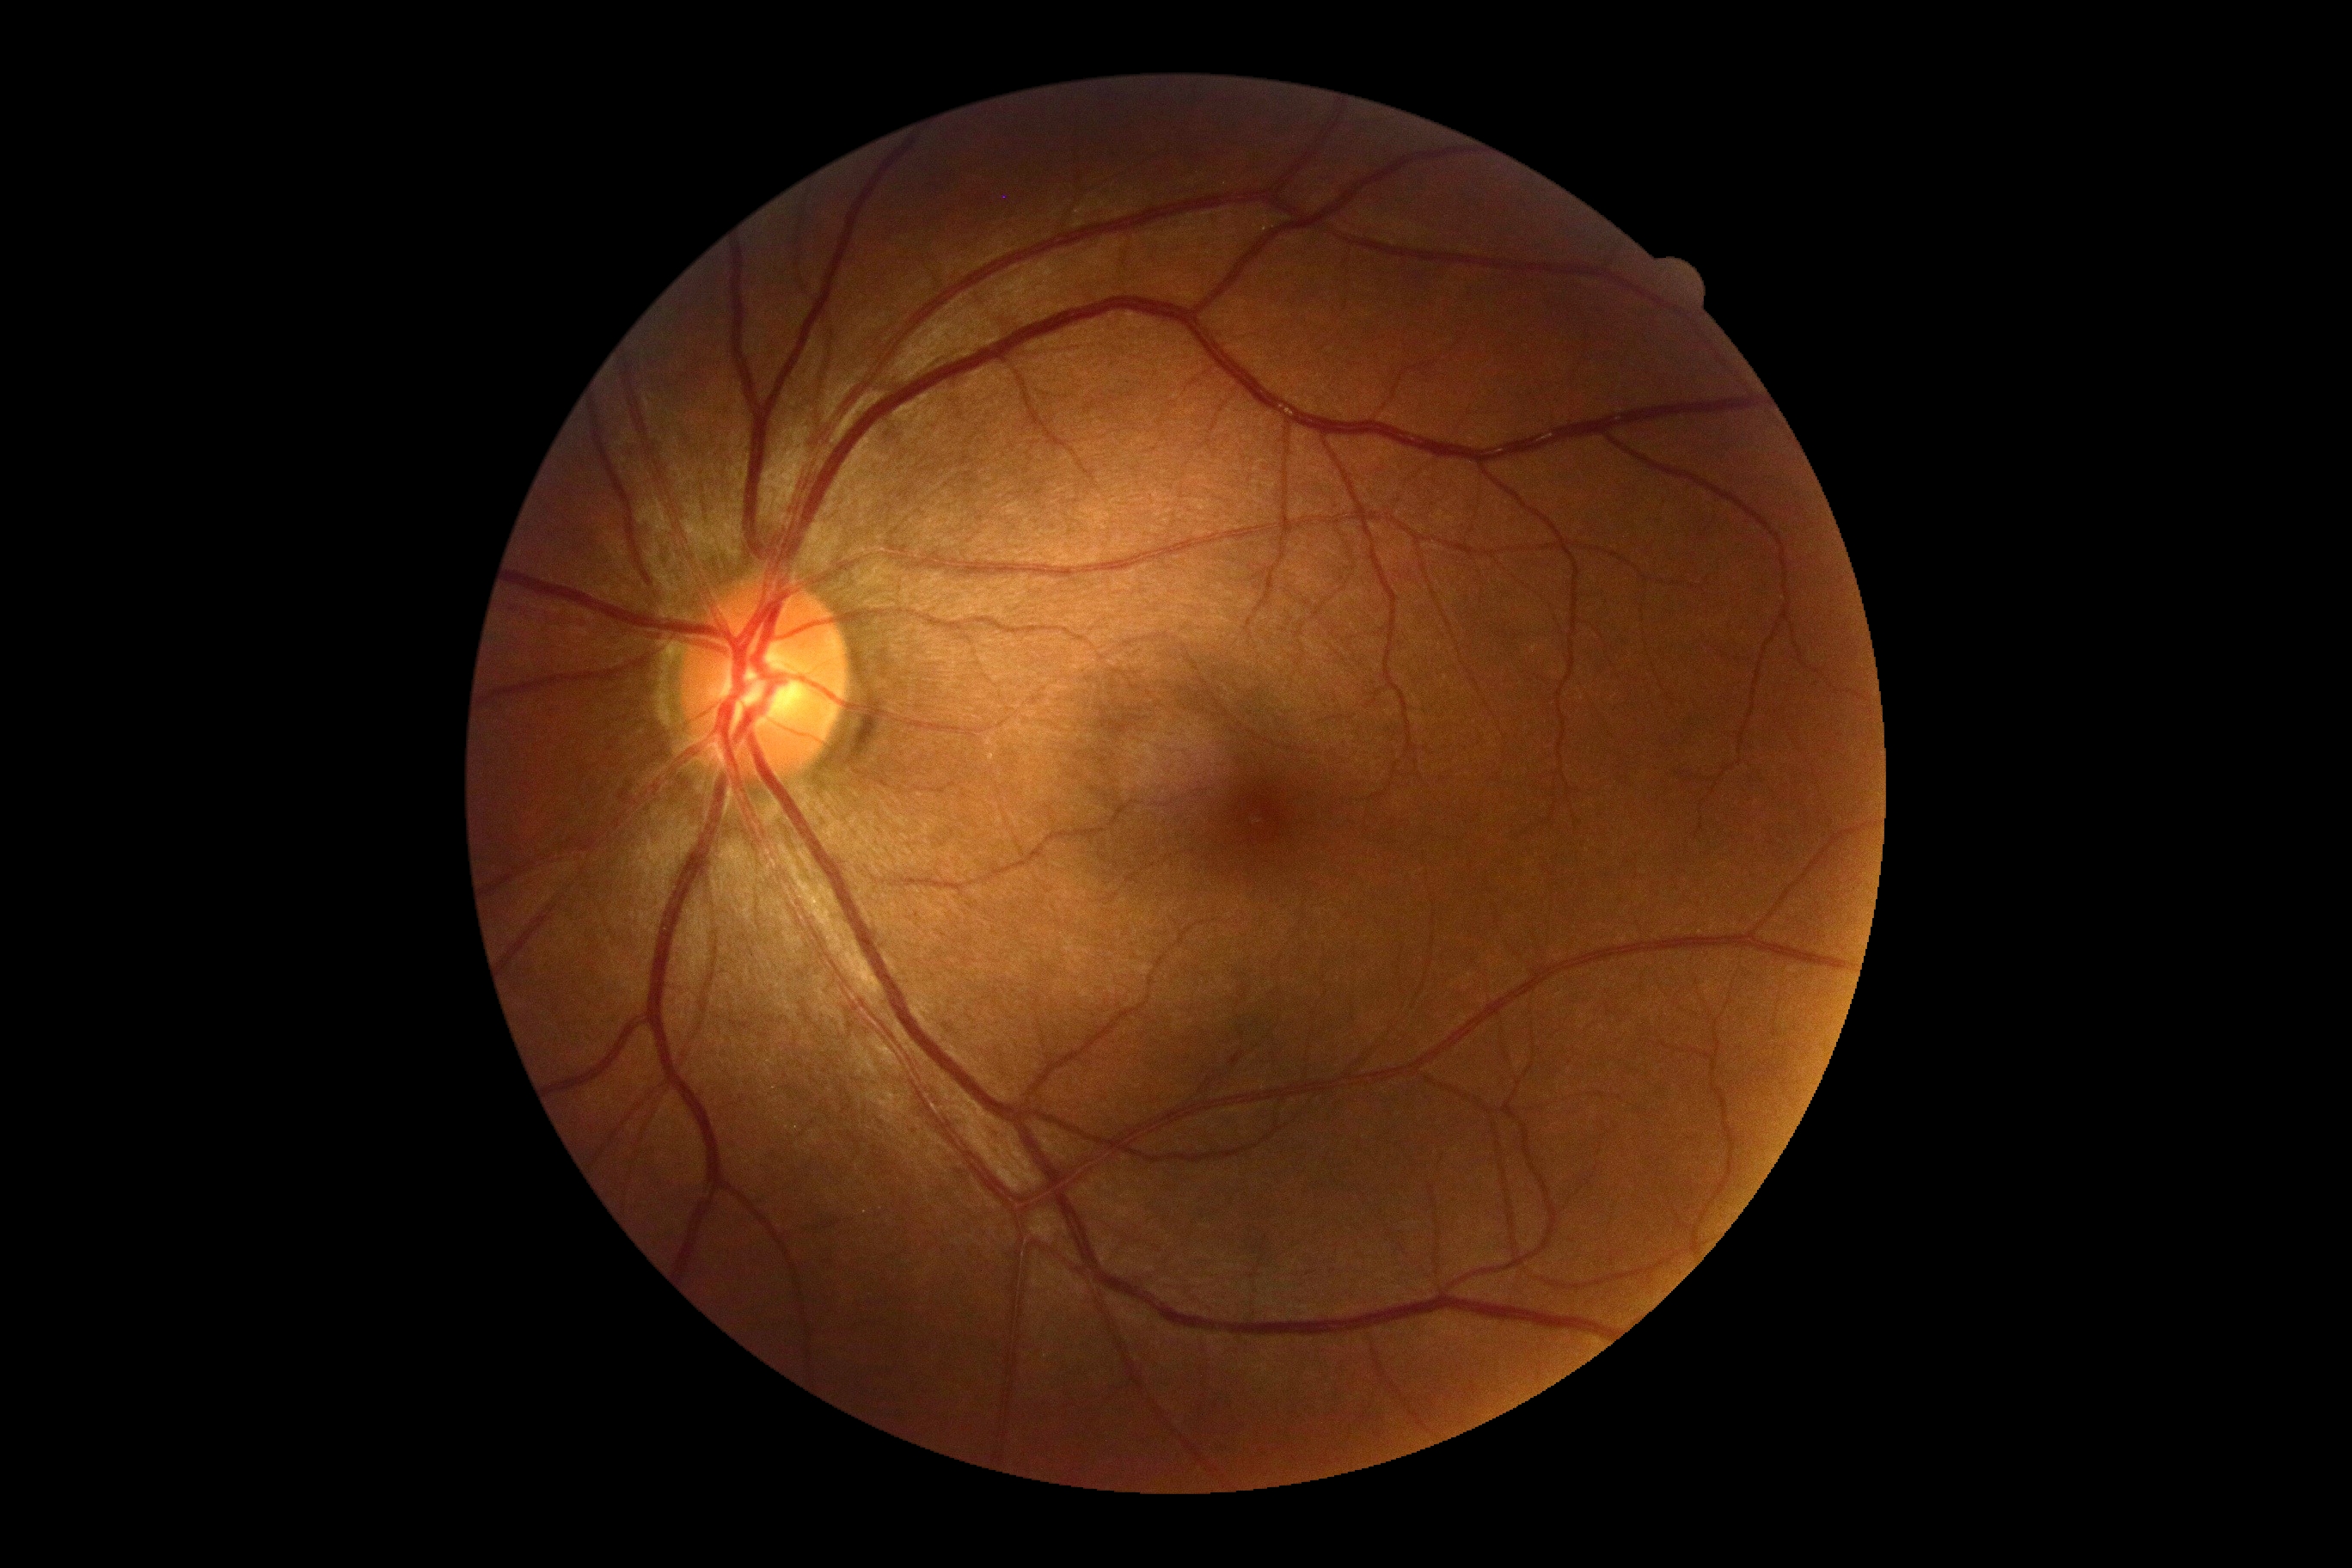 DR: 0/4.